Retinal fundus photograph: 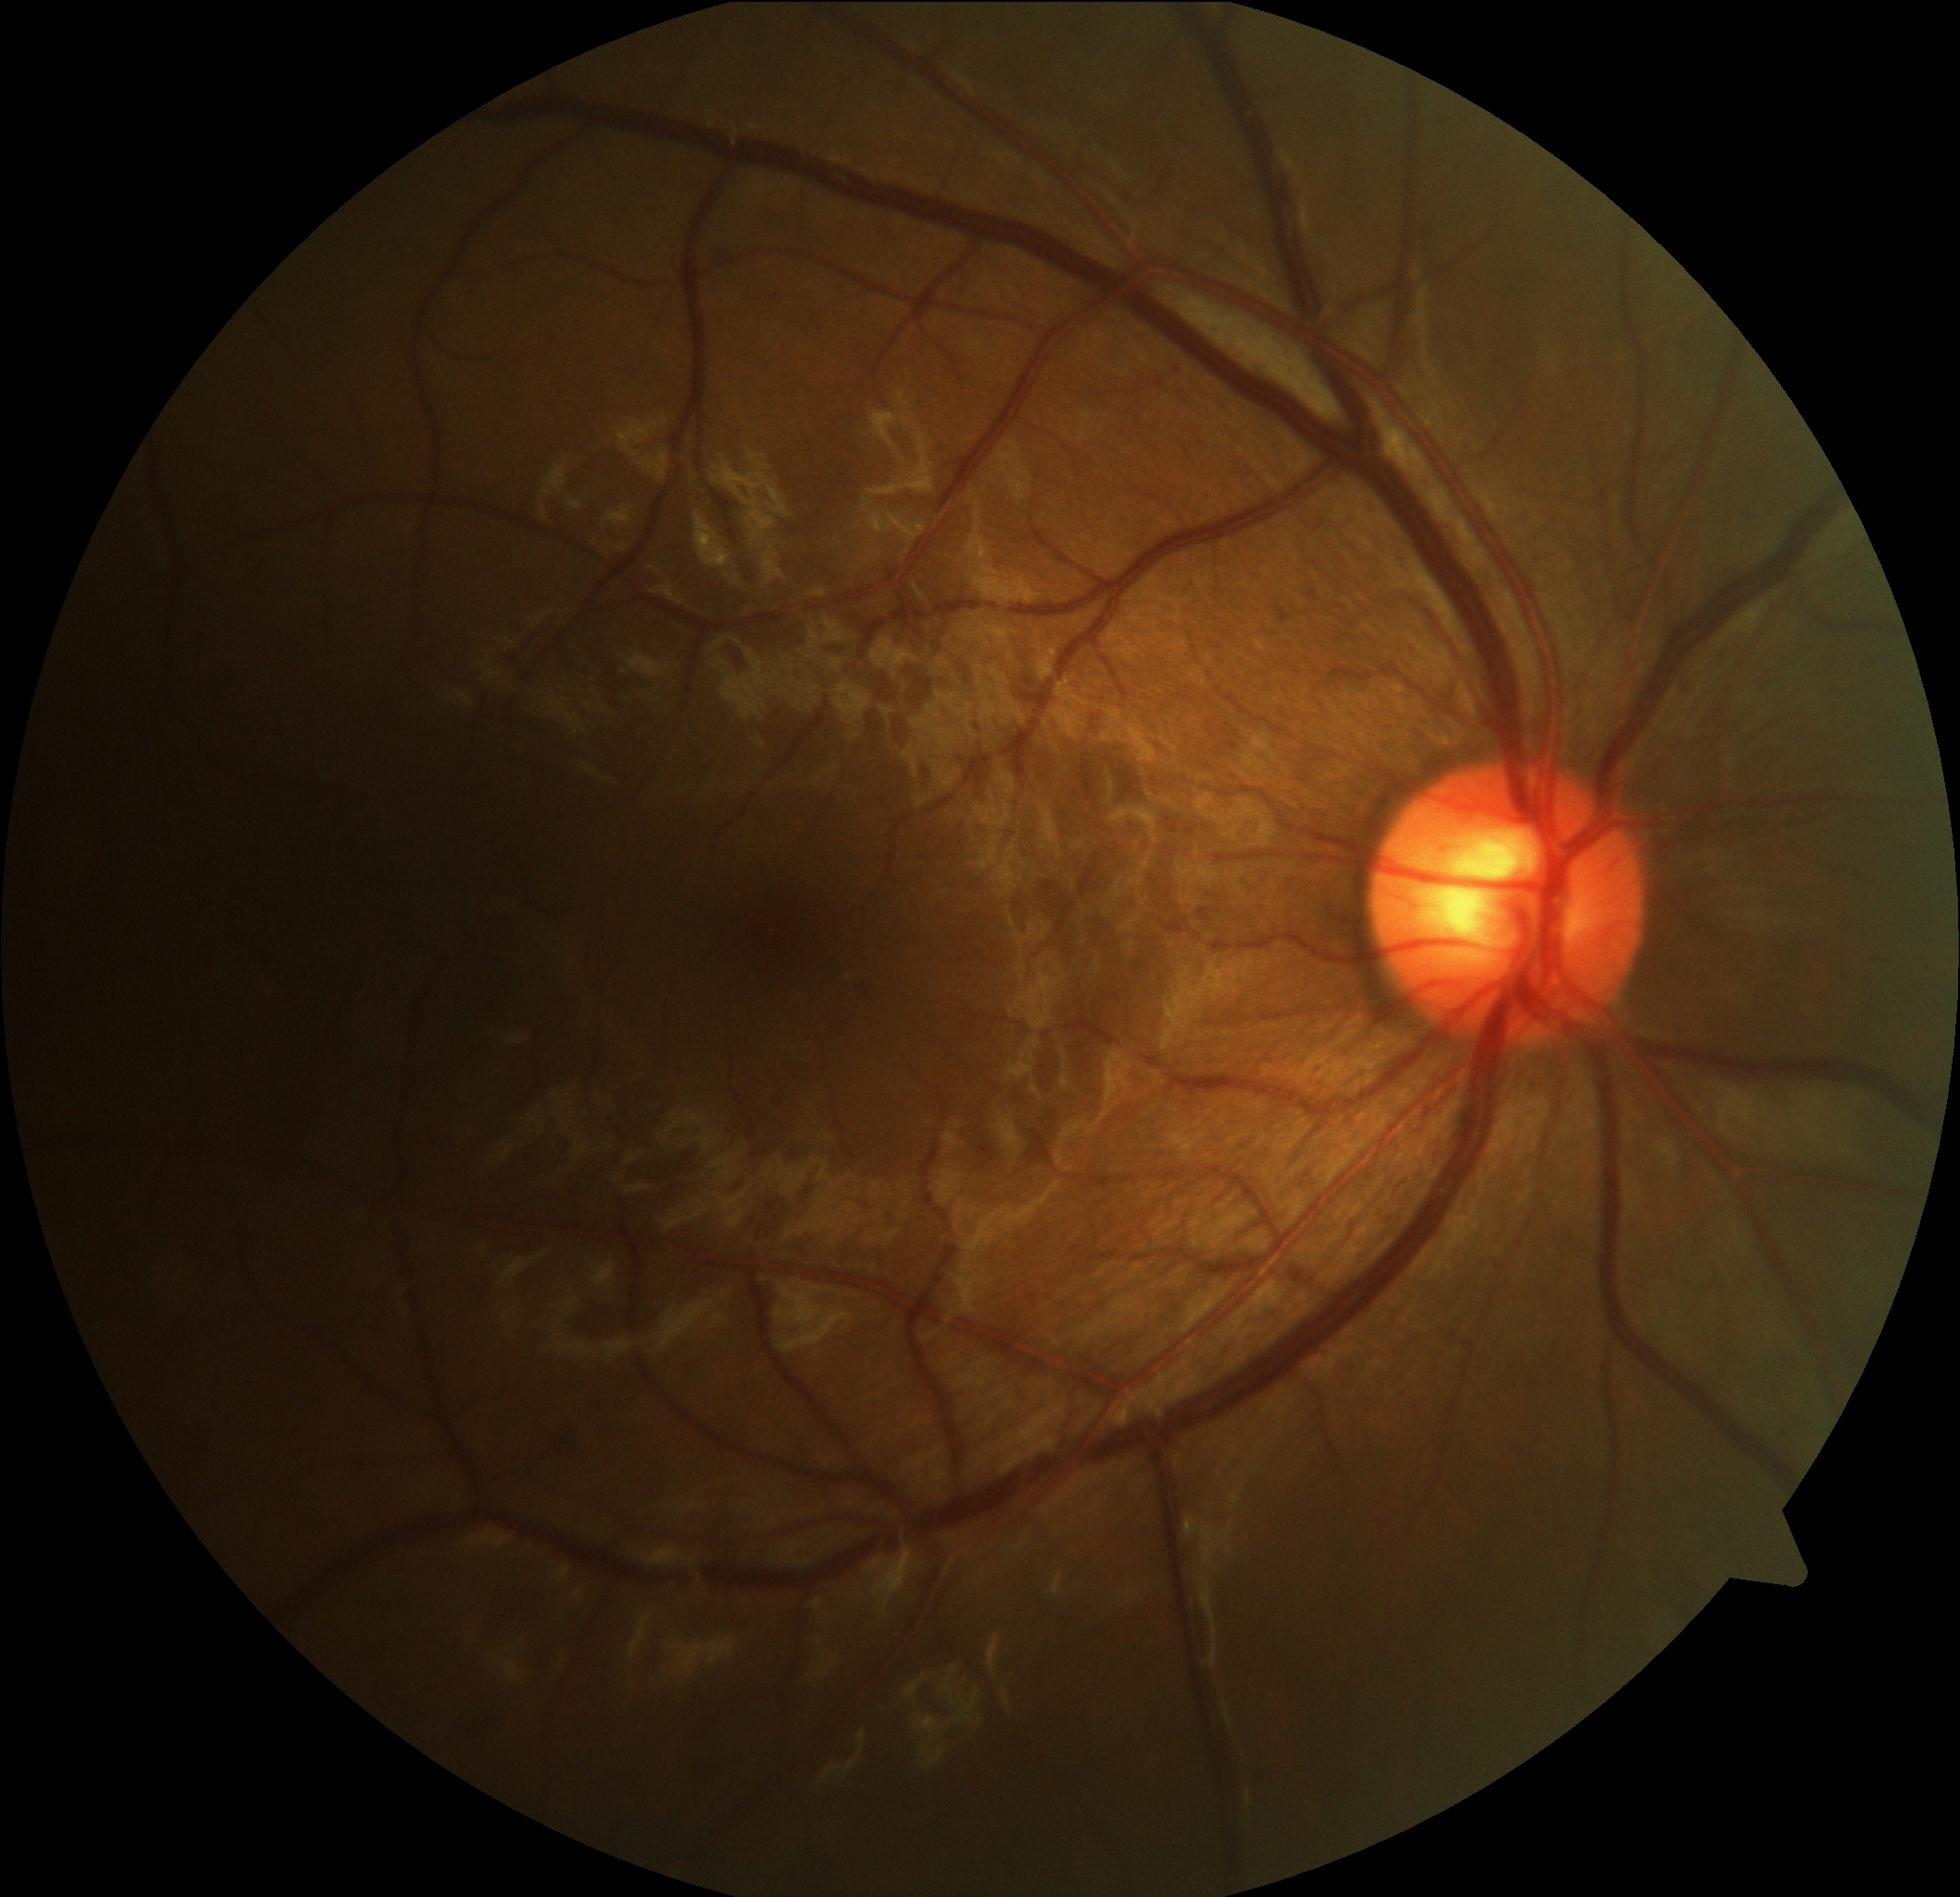

Retinopathy is grade 2 (moderate NPDR).